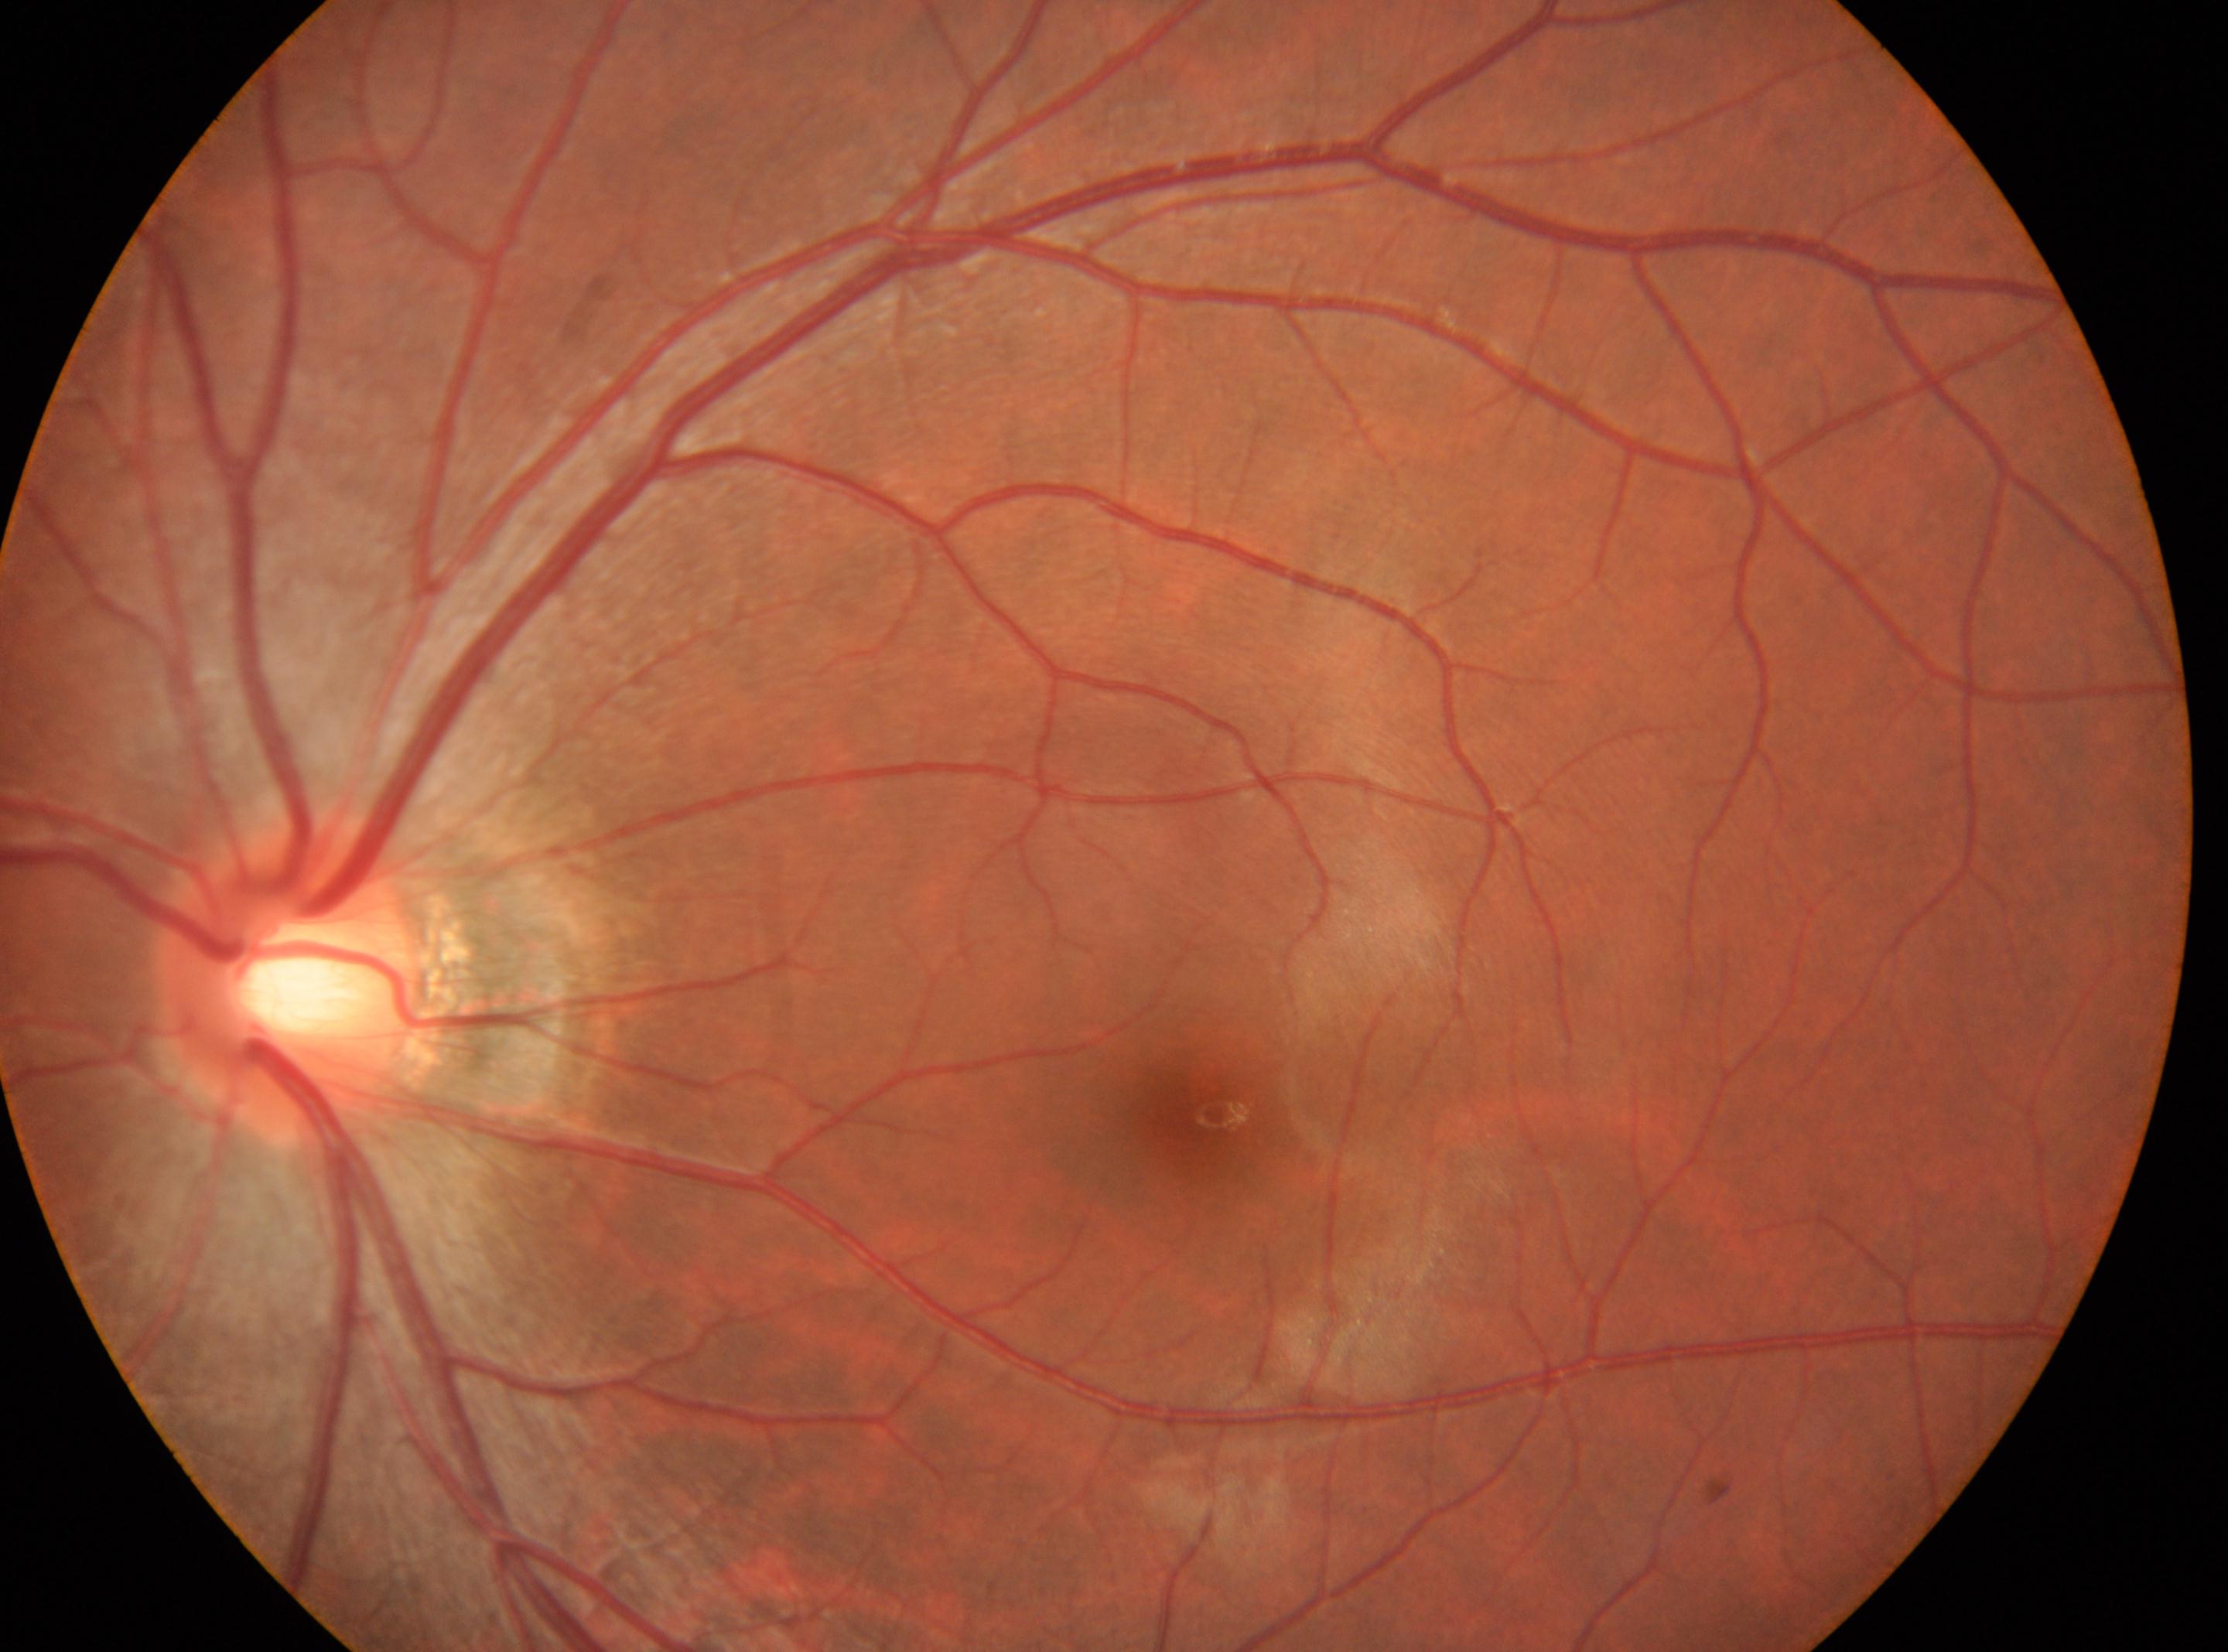

The fovea is at (x: 1211, y: 1115). The optic disc center is at (x: 292, y: 982). Diabetic retinopathy (DR) is grade 0 (no apparent retinopathy) — no visible signs of diabetic retinopathy. The image shows the left eye. No apparent diabetic retinopathy.